2212x1659px · CFP: 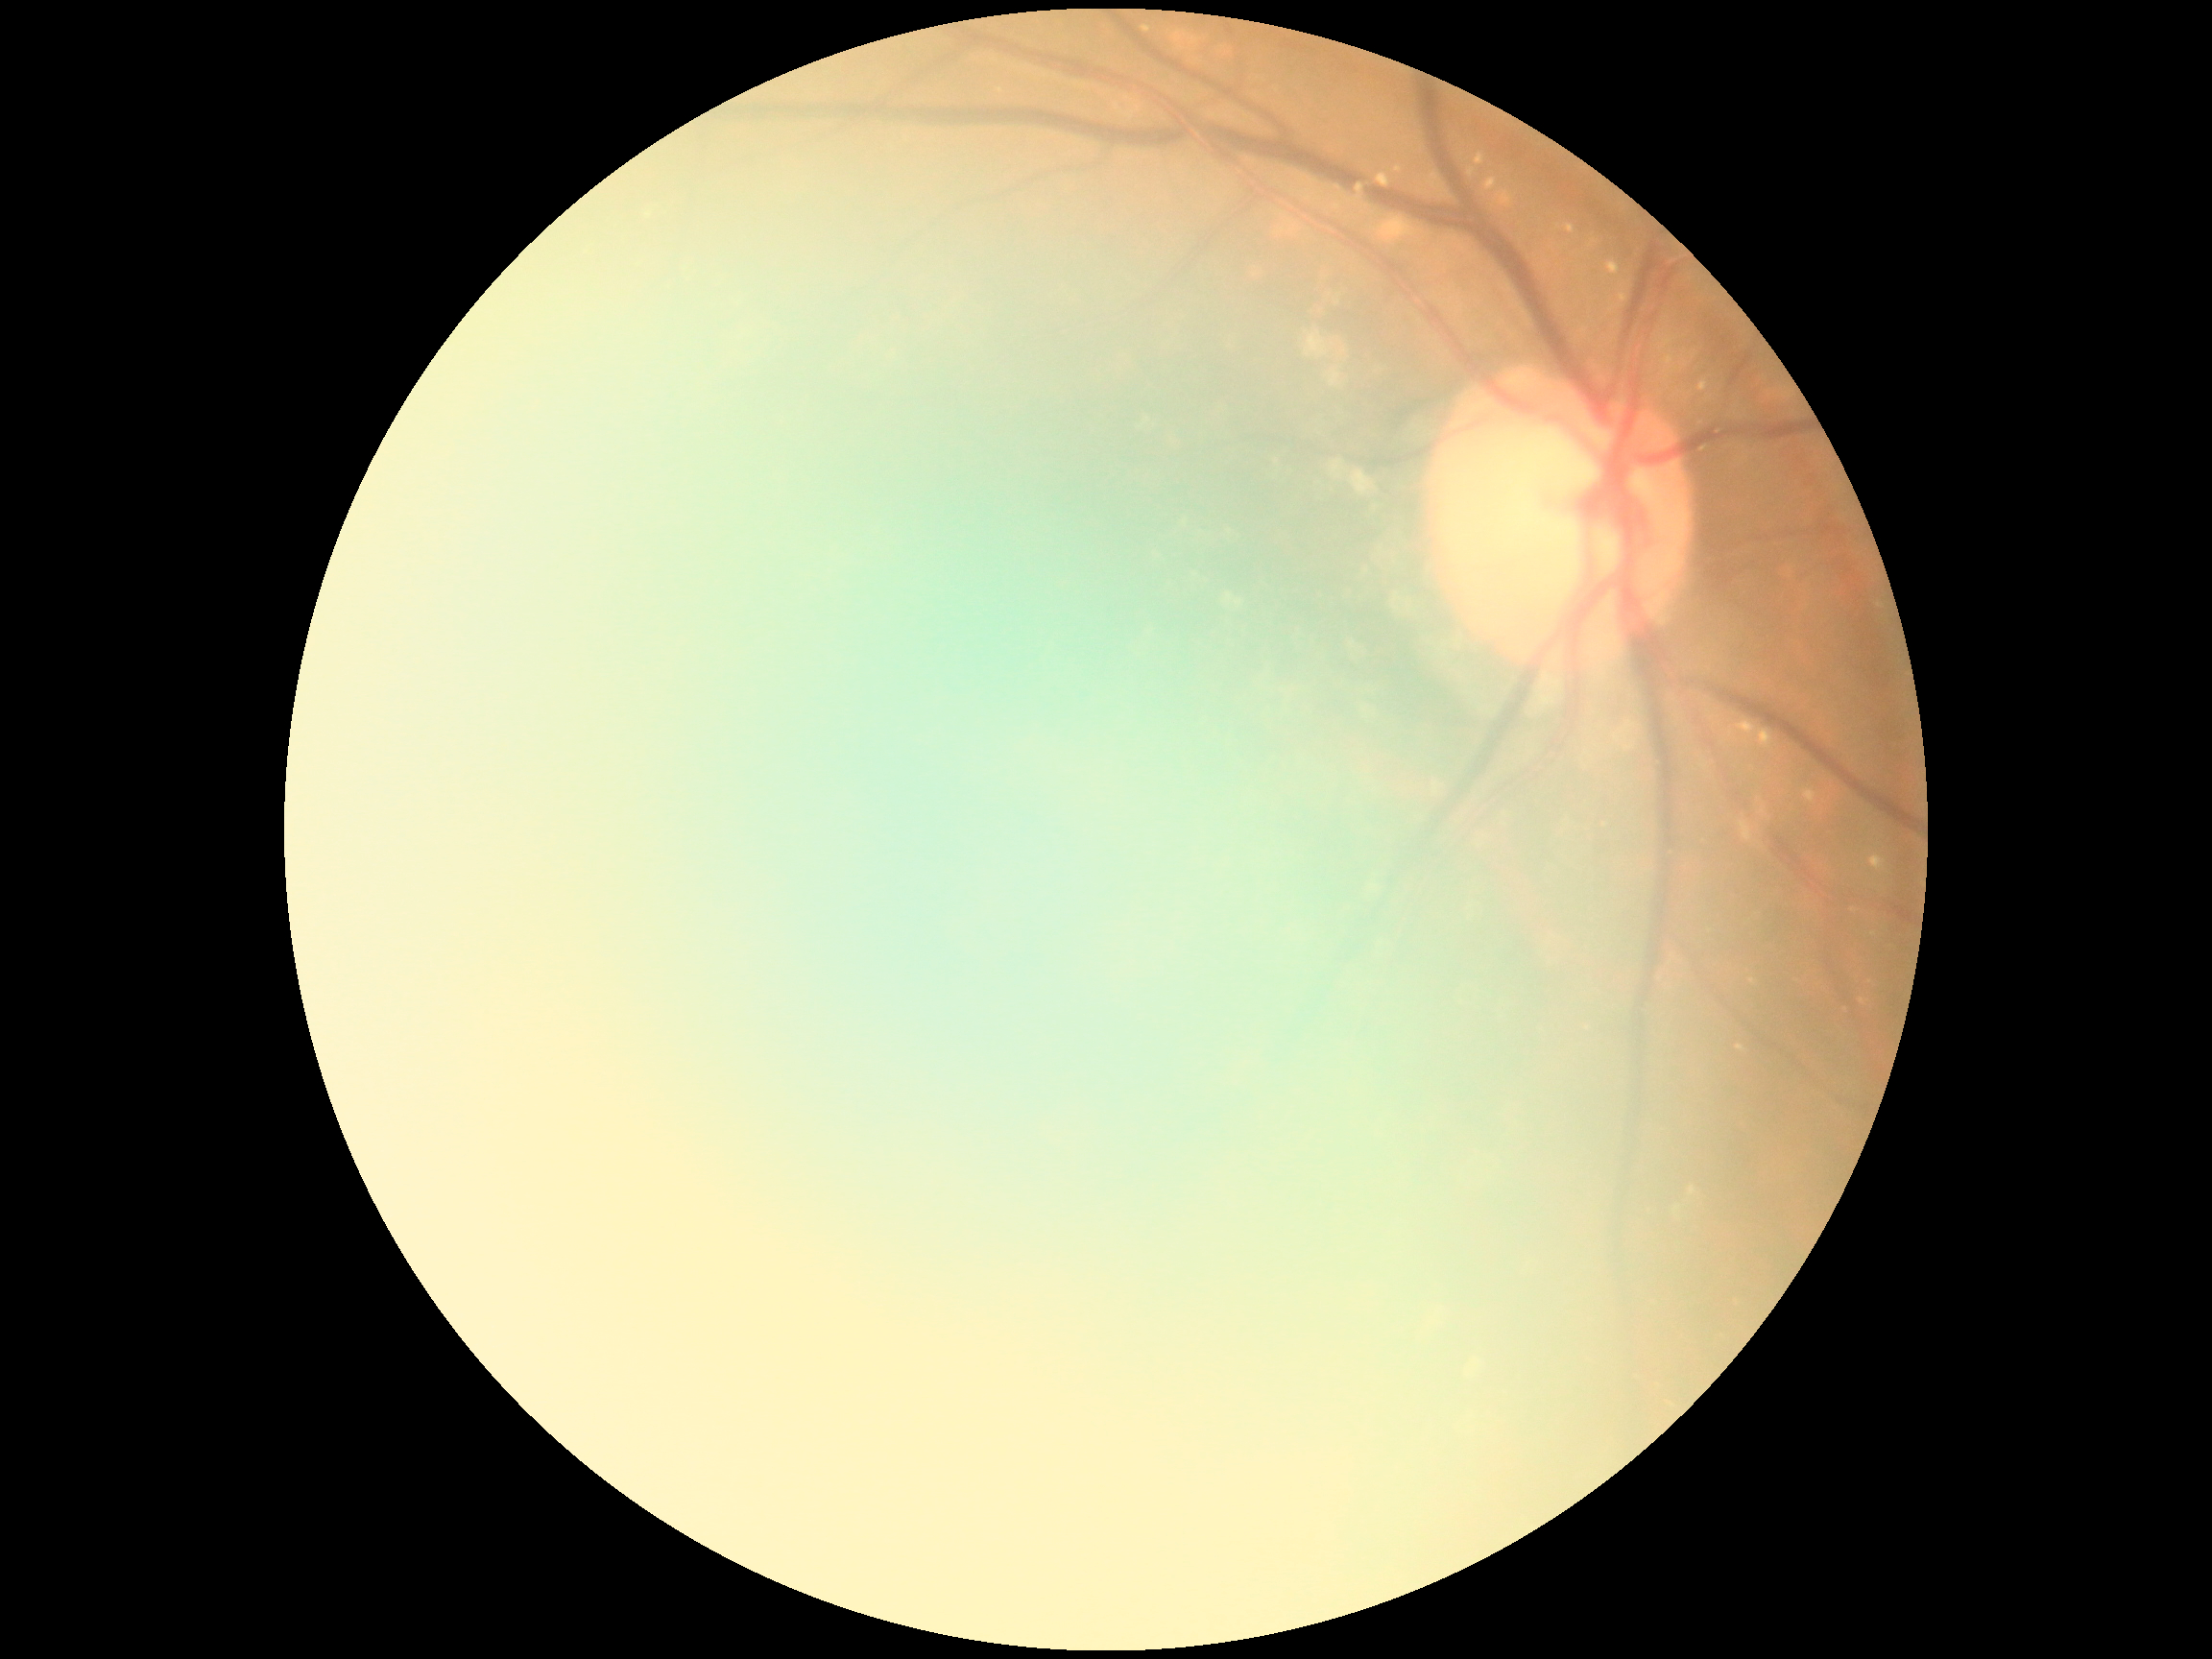
- DR: ungradable